45° field of view.
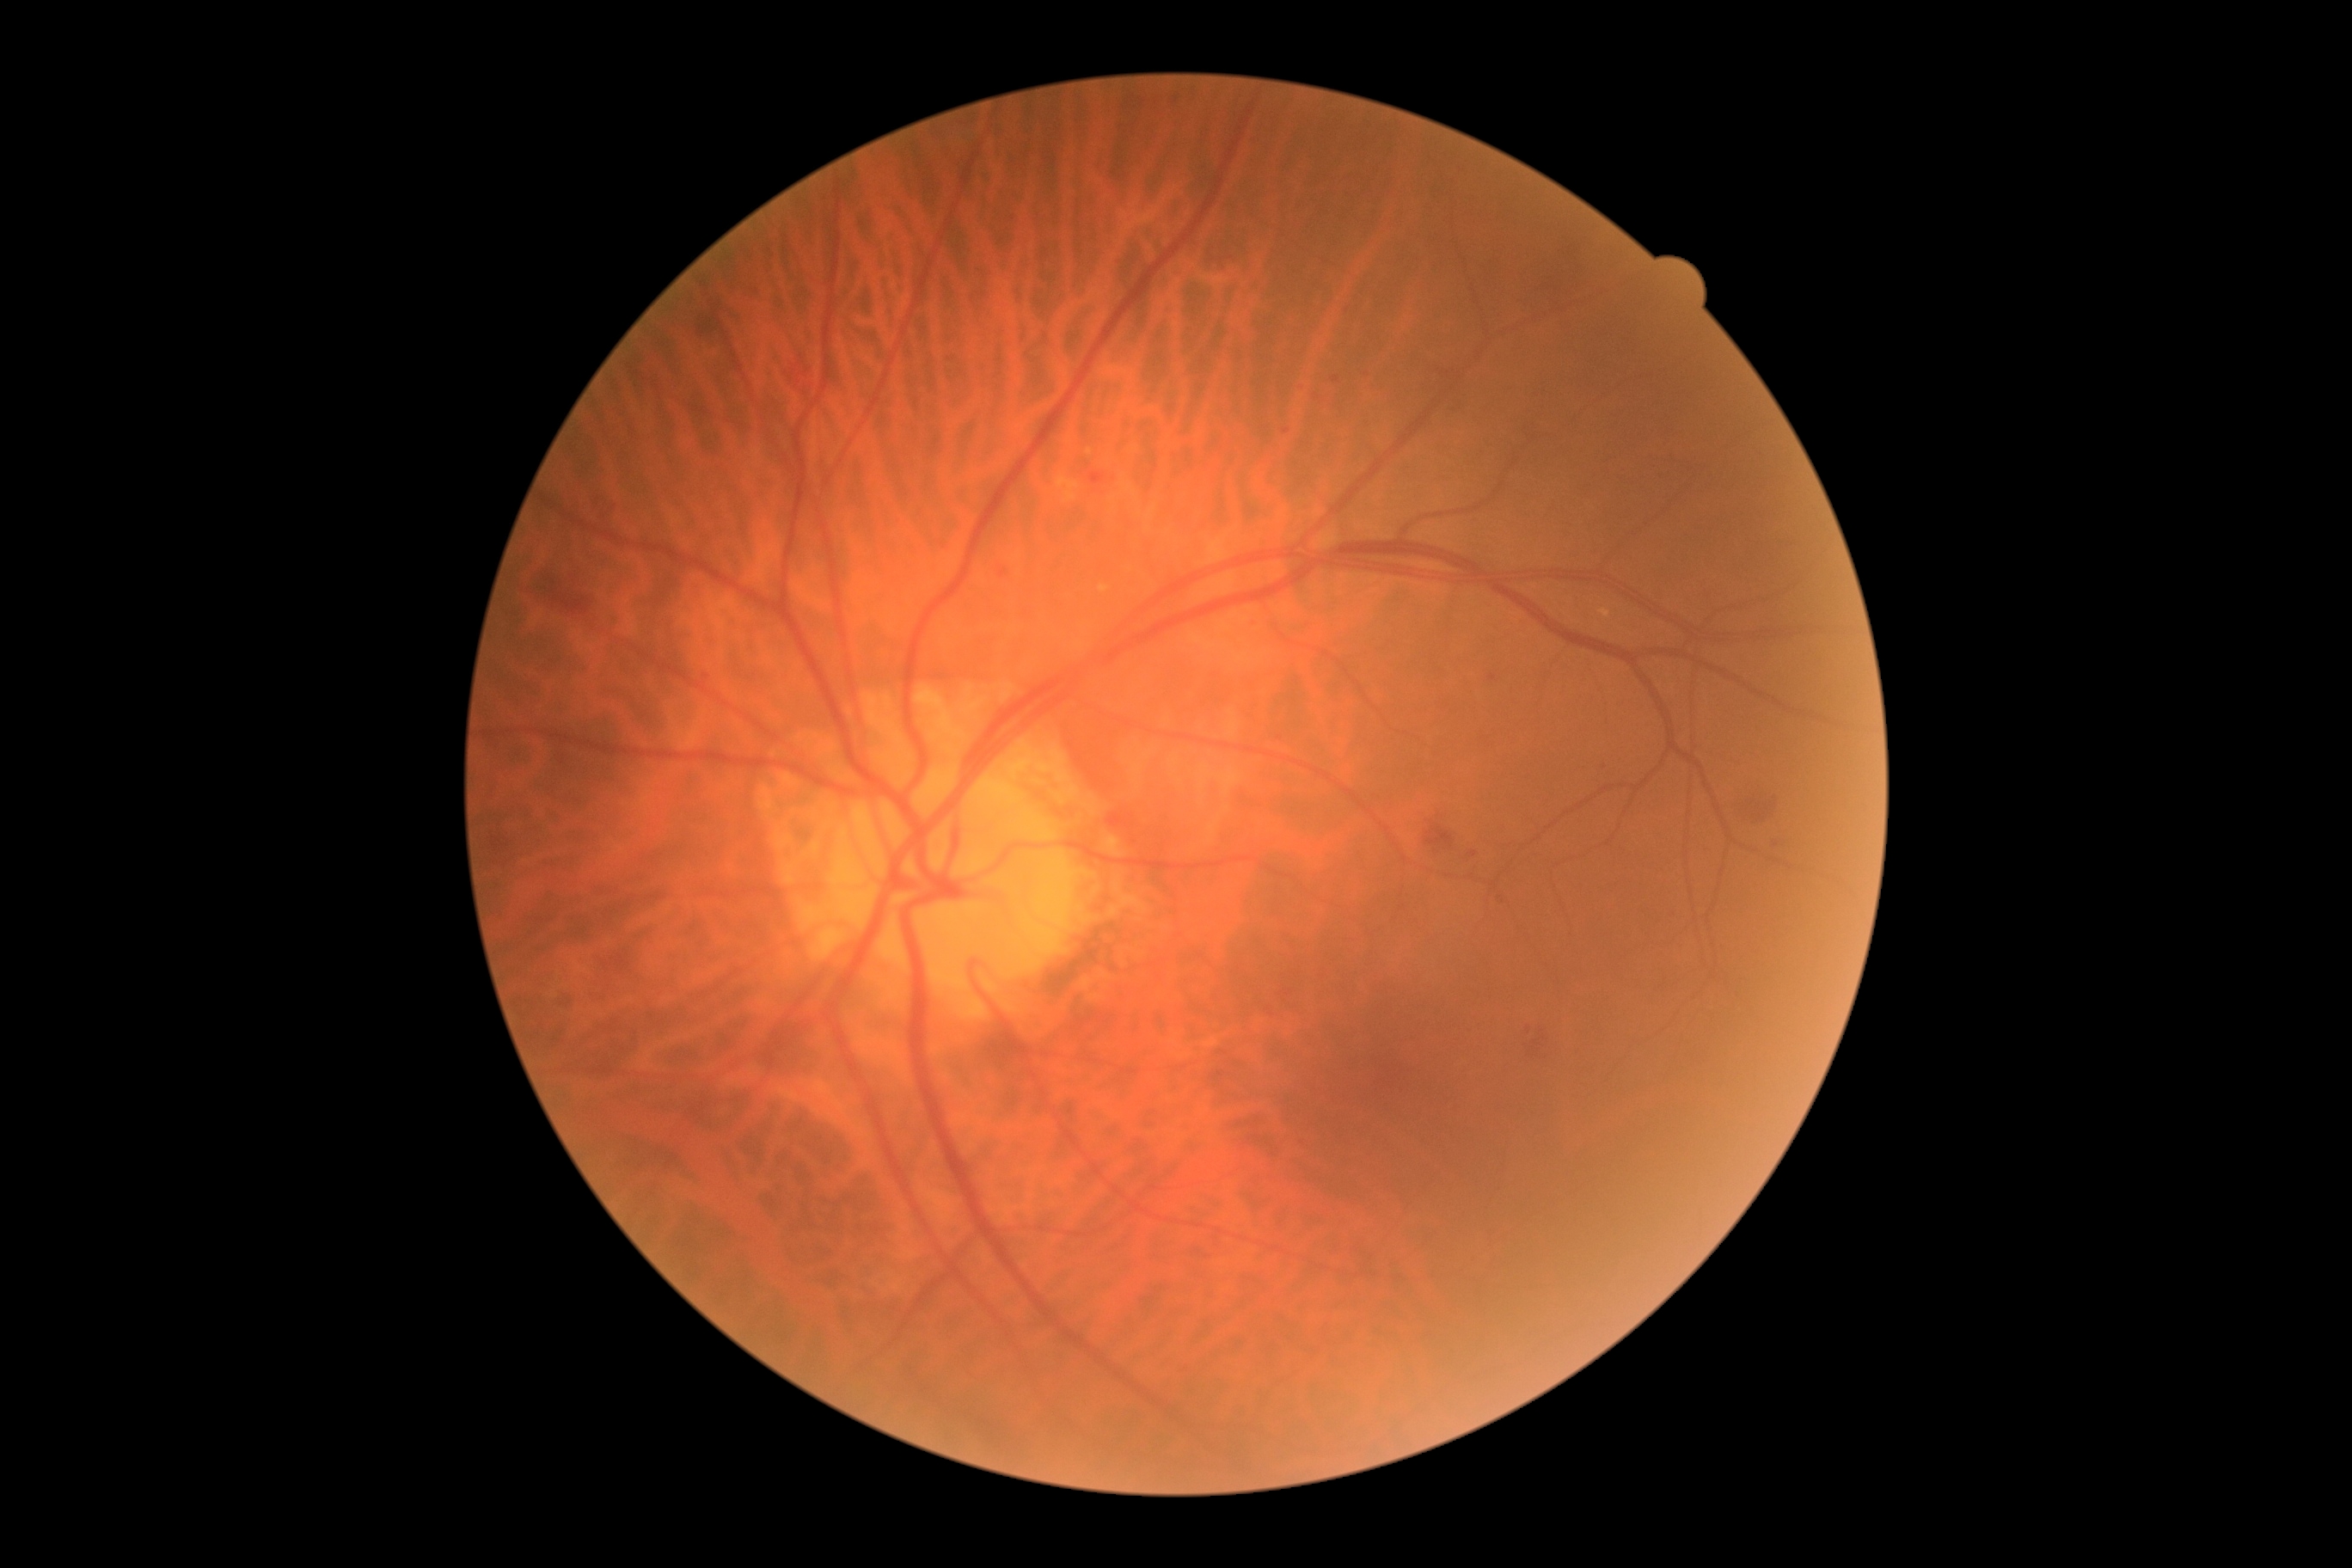
Diabetic retinopathy severity is moderate non-proliferative diabetic retinopathy (grade 2).